Captured on a Nidek AFC-330 fundus camera; non-mydriatic acquisition.
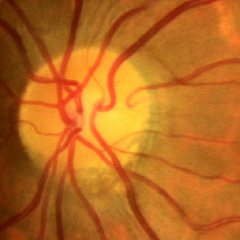

Glaucoma stage: no signs of glaucoma.